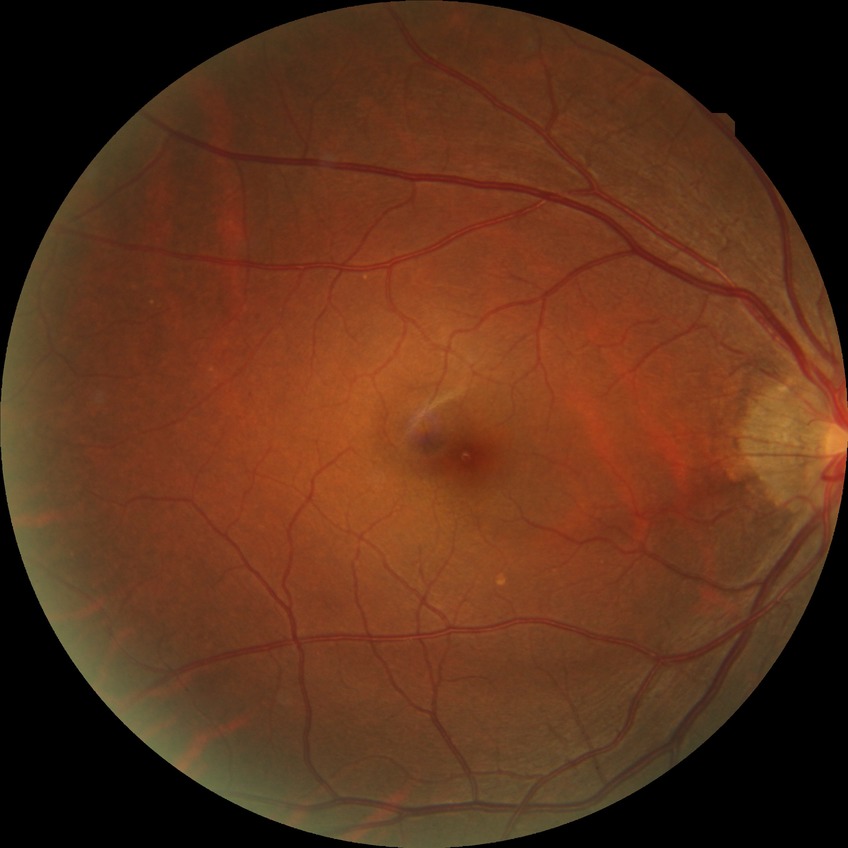
diabetic retinopathy (DR): no diabetic retinopathy (NDR).